Wide-field retinal mosaic image — 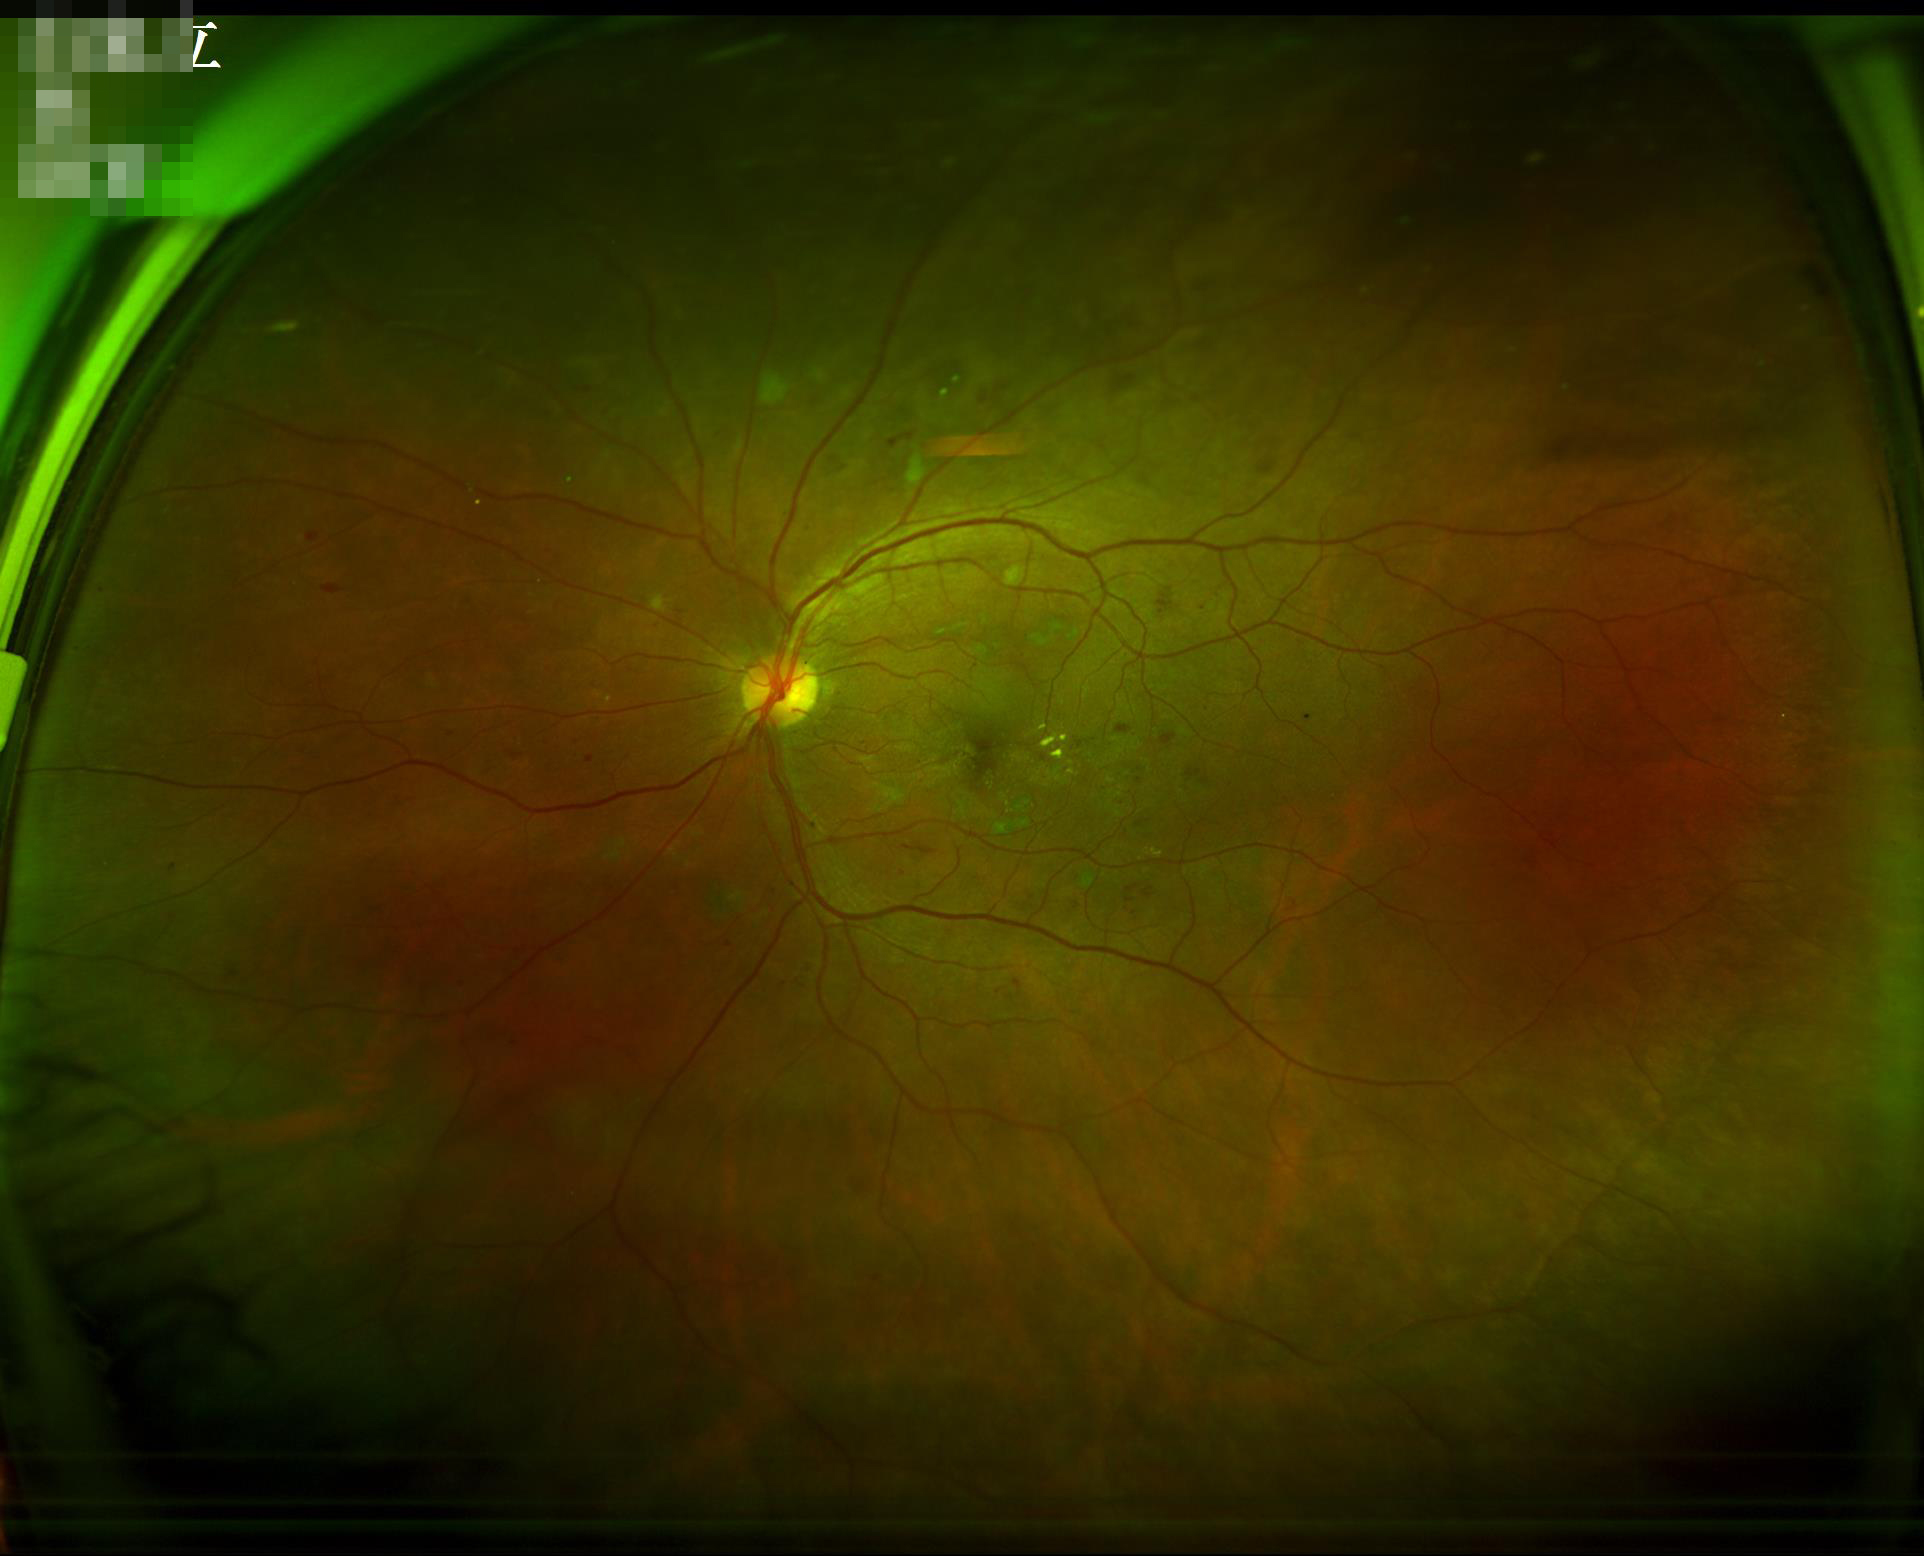 Overall image quality = acceptable | Contrast = satisfactory.